45 degree fundus photograph, 848 by 848 pixels, nonmydriatic:
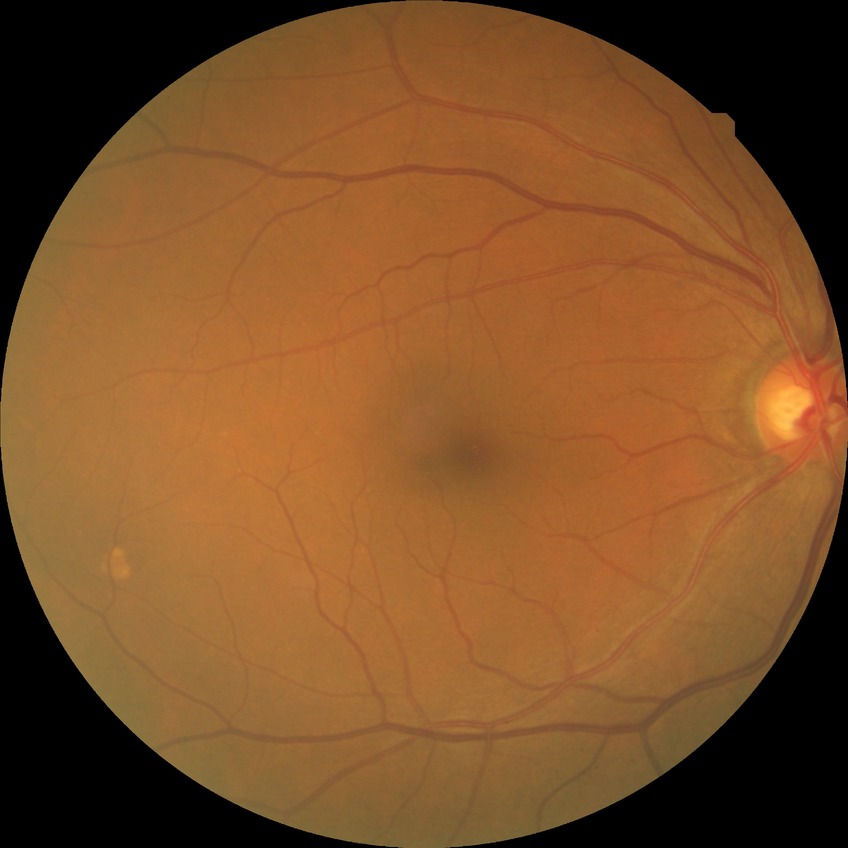

Diabetic retinopathy (DR): NDR (no diabetic retinopathy).